Modified Davis grading — 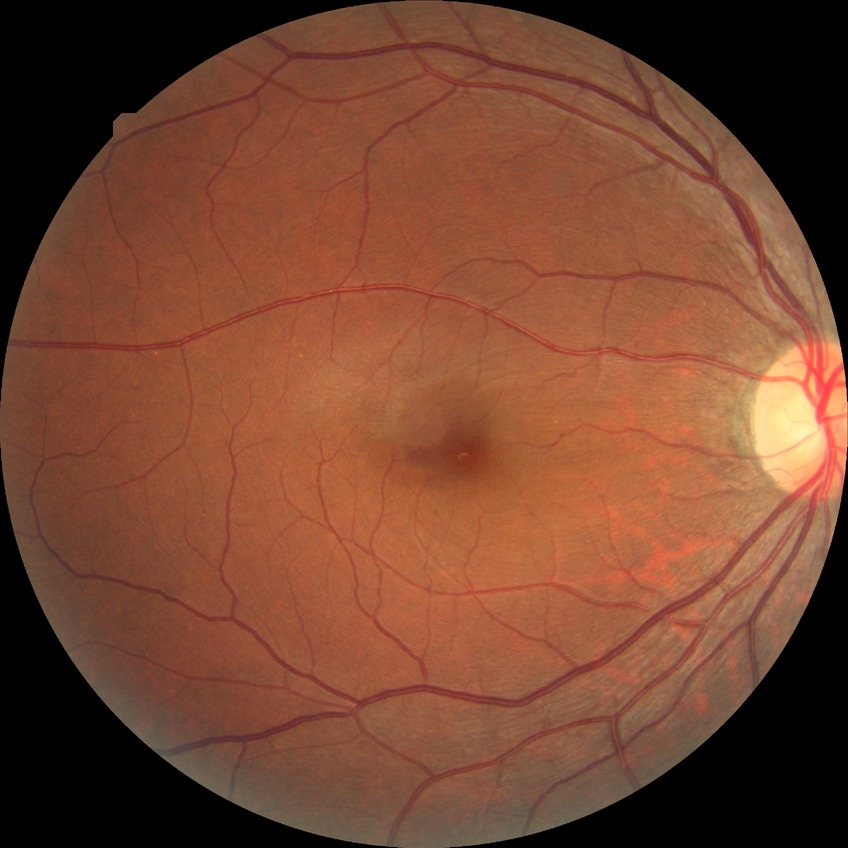
* diabetic retinopathy (DR) — NDR (no diabetic retinopathy)